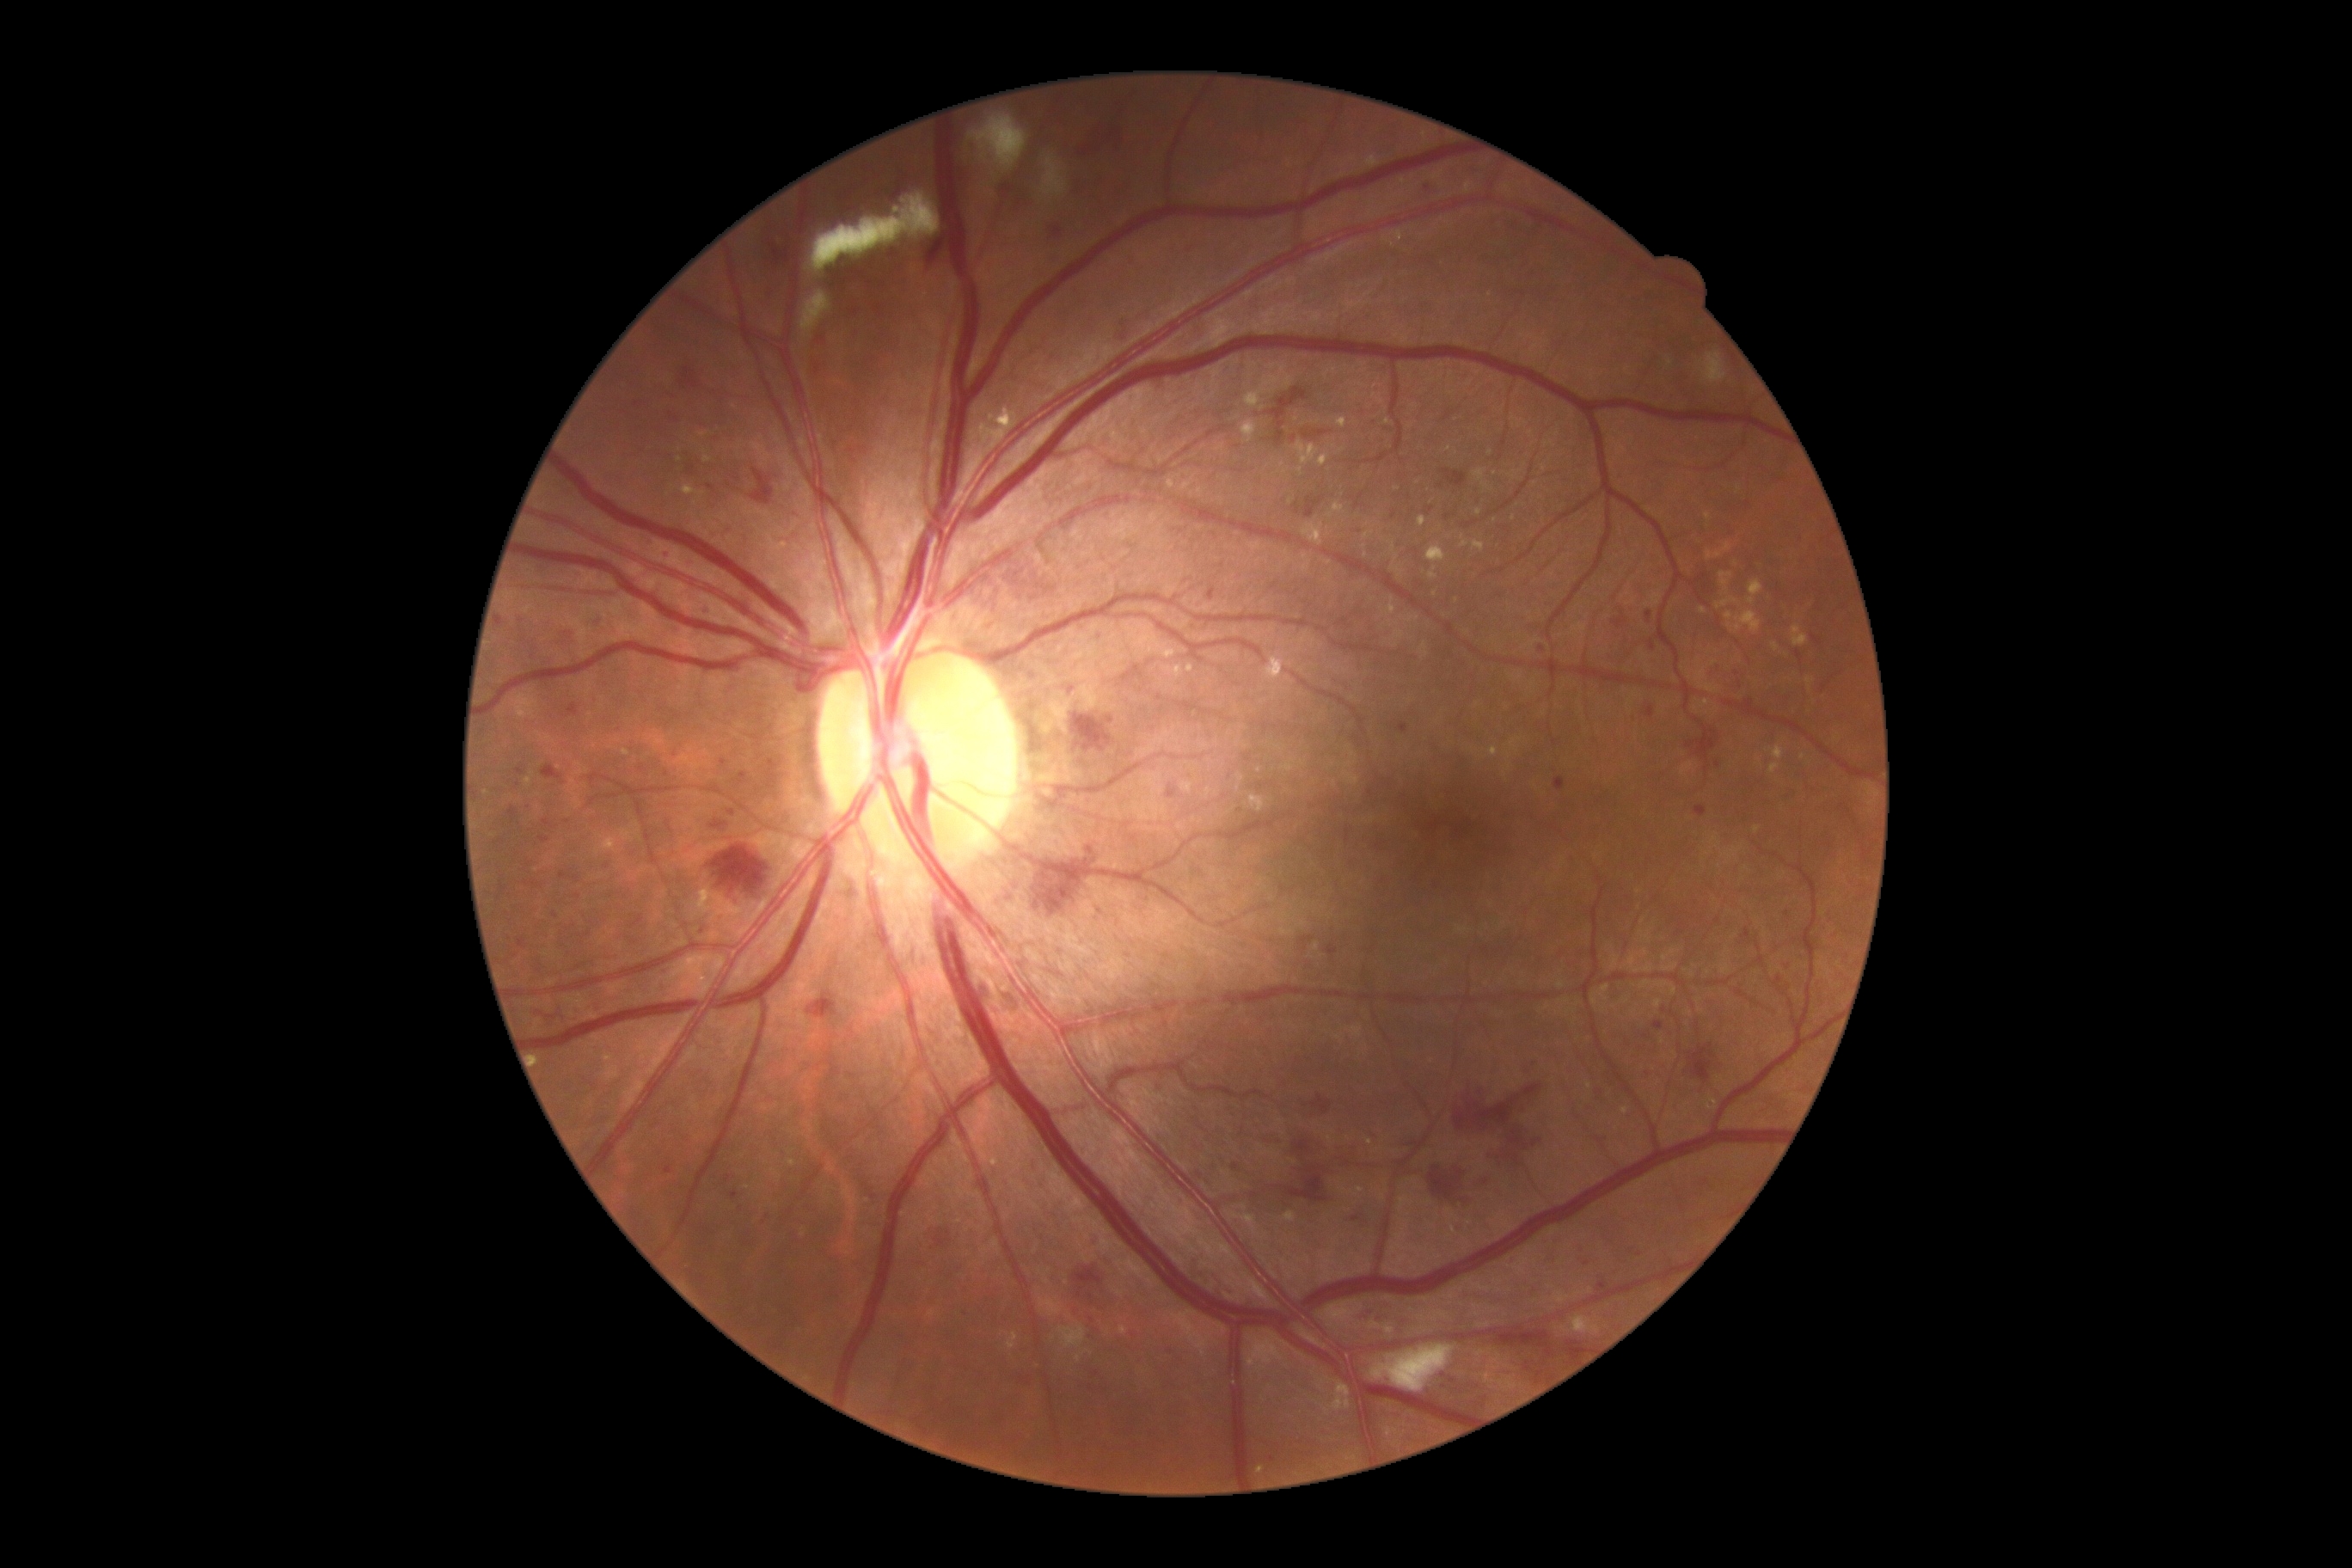

DR severity is 3
Lesions identified (partial list):
• EXs (more not shown): (1075, 1351, 1093, 1363); (1423, 133, 1428, 145); (1328, 503, 1345, 518); (1295, 441, 1320, 465); (1156, 644, 1177, 659); (1283, 1213, 1295, 1223); (1426, 544, 1447, 563); (603, 1055, 615, 1062); (1461, 536, 1469, 548); (1485, 1375, 1491, 1383)
• EXs (small, approximate centers) near x=1369 y=1142; x=1489 y=453; x=1259 y=770; x=1639 y=892; x=1802 y=758; x=1703 y=611; x=1360 y=1189
• MAs (more not shown): (709, 609, 718, 616); (665, 1167, 673, 1175); (1094, 634, 1099, 642); (1168, 788, 1179, 799); (1612, 613, 1627, 630); (1232, 1163, 1239, 1172); (567, 704, 579, 718); (560, 873, 570, 879); (1645, 706, 1655, 720); (1653, 1022, 1663, 1031); (1461, 1201, 1474, 1208)
• MAs (small, approximate centers) near x=1092 y=1321; x=1787 y=914; x=669 y=556; x=702 y=931; x=521 y=621; x=1500 y=950; x=729 y=1179; x=1537 y=1064